Image size 2352x1568; FOV: 45 degrees; CFP:
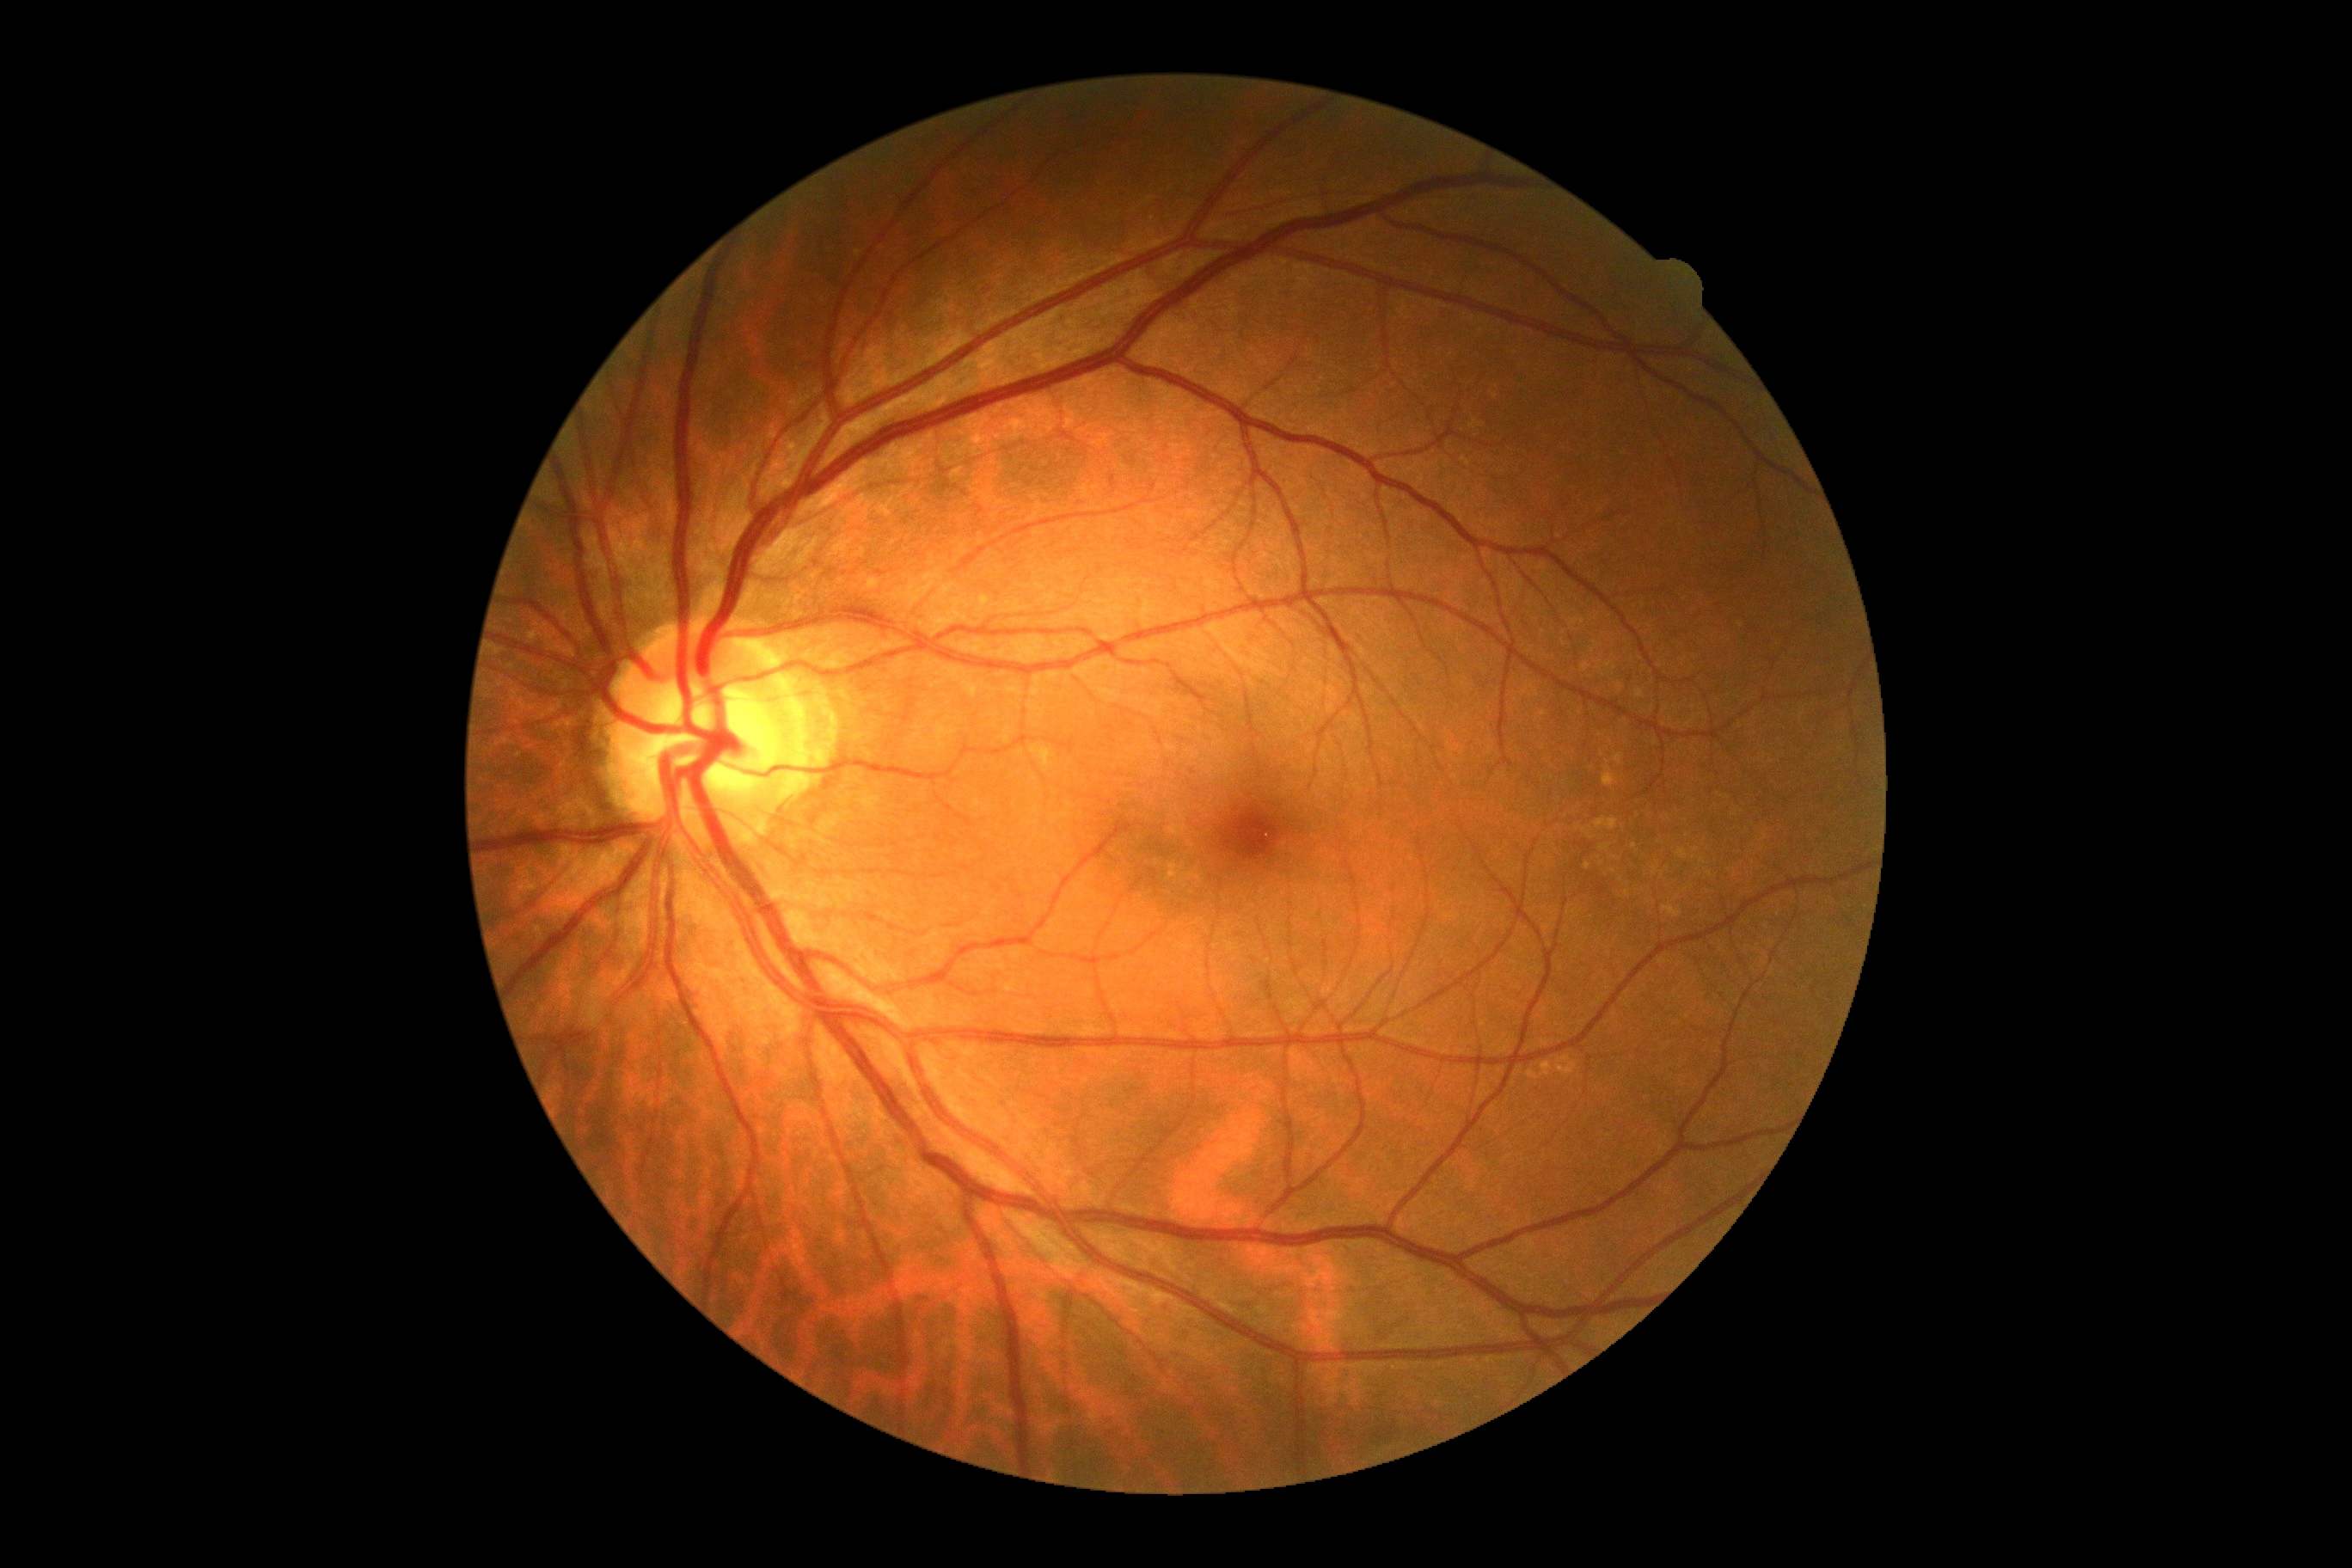

DR grade: 0.